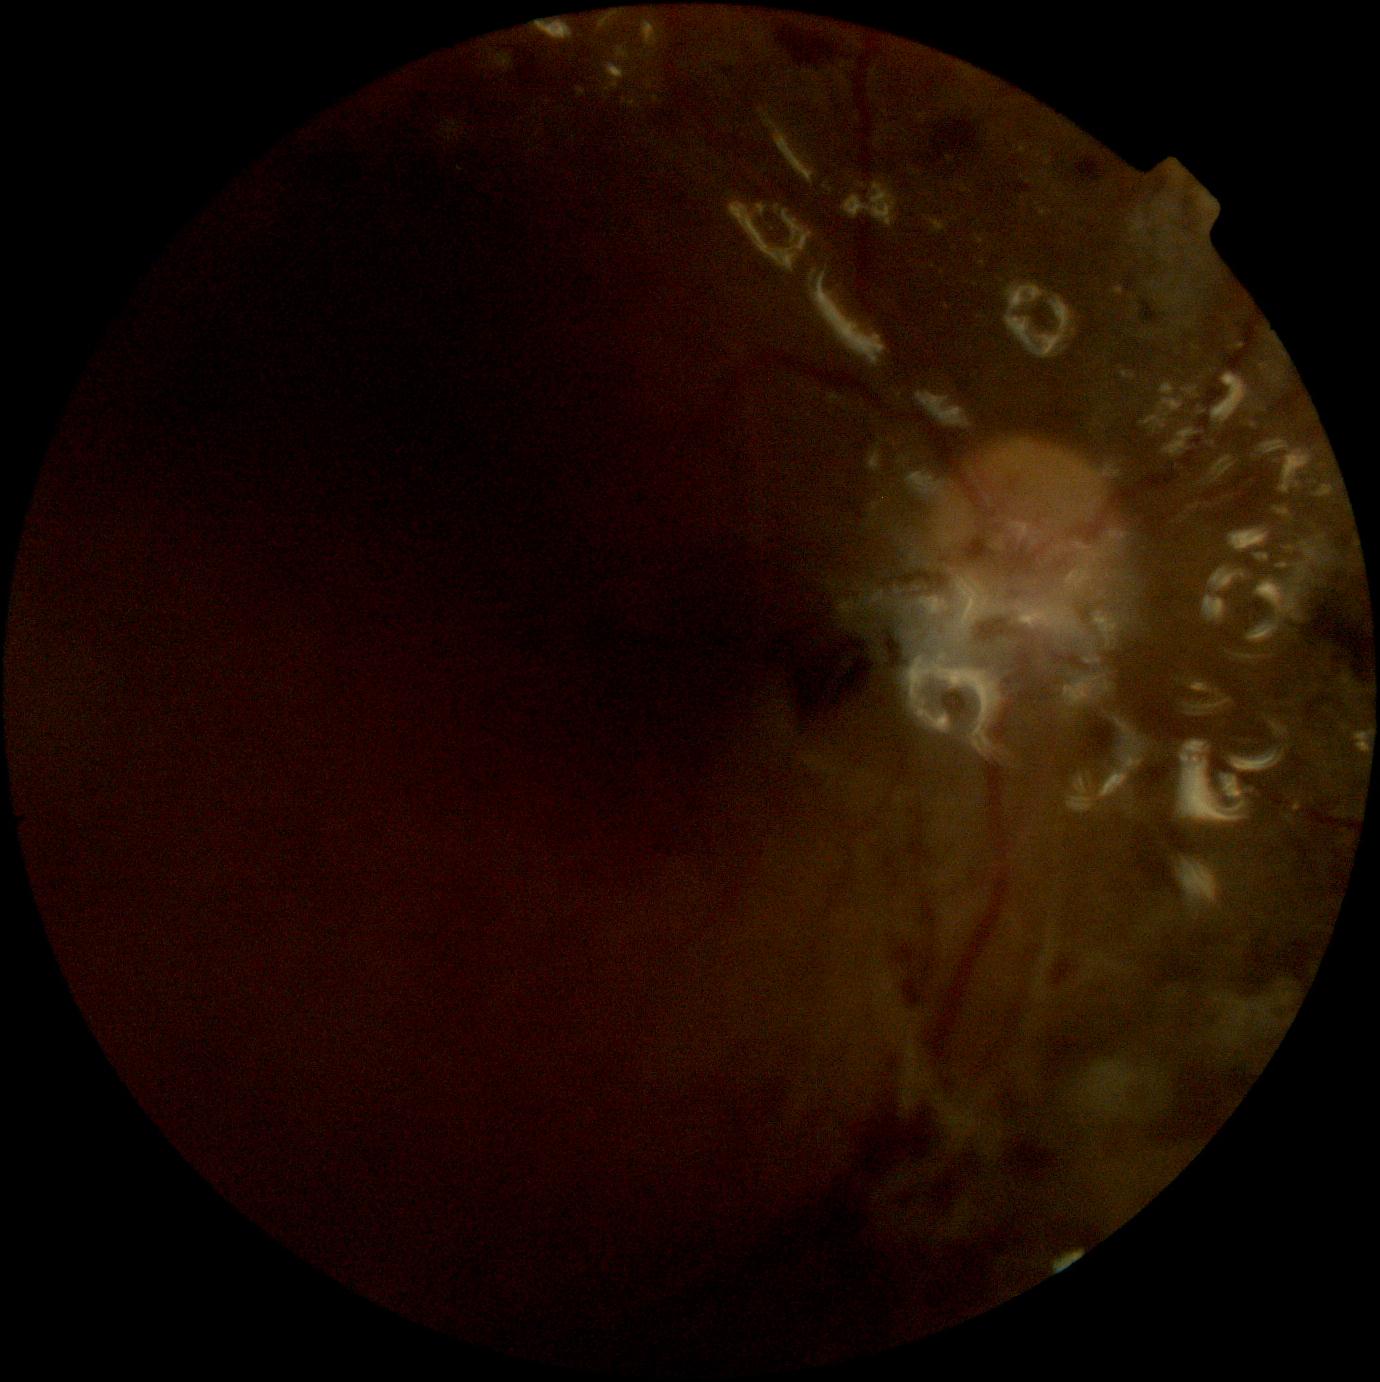 DR severity is ungradable due to poor image quality. Image quality is insufficient for diabetic retinopathy assessment.